2352x1568 · color fundus image: 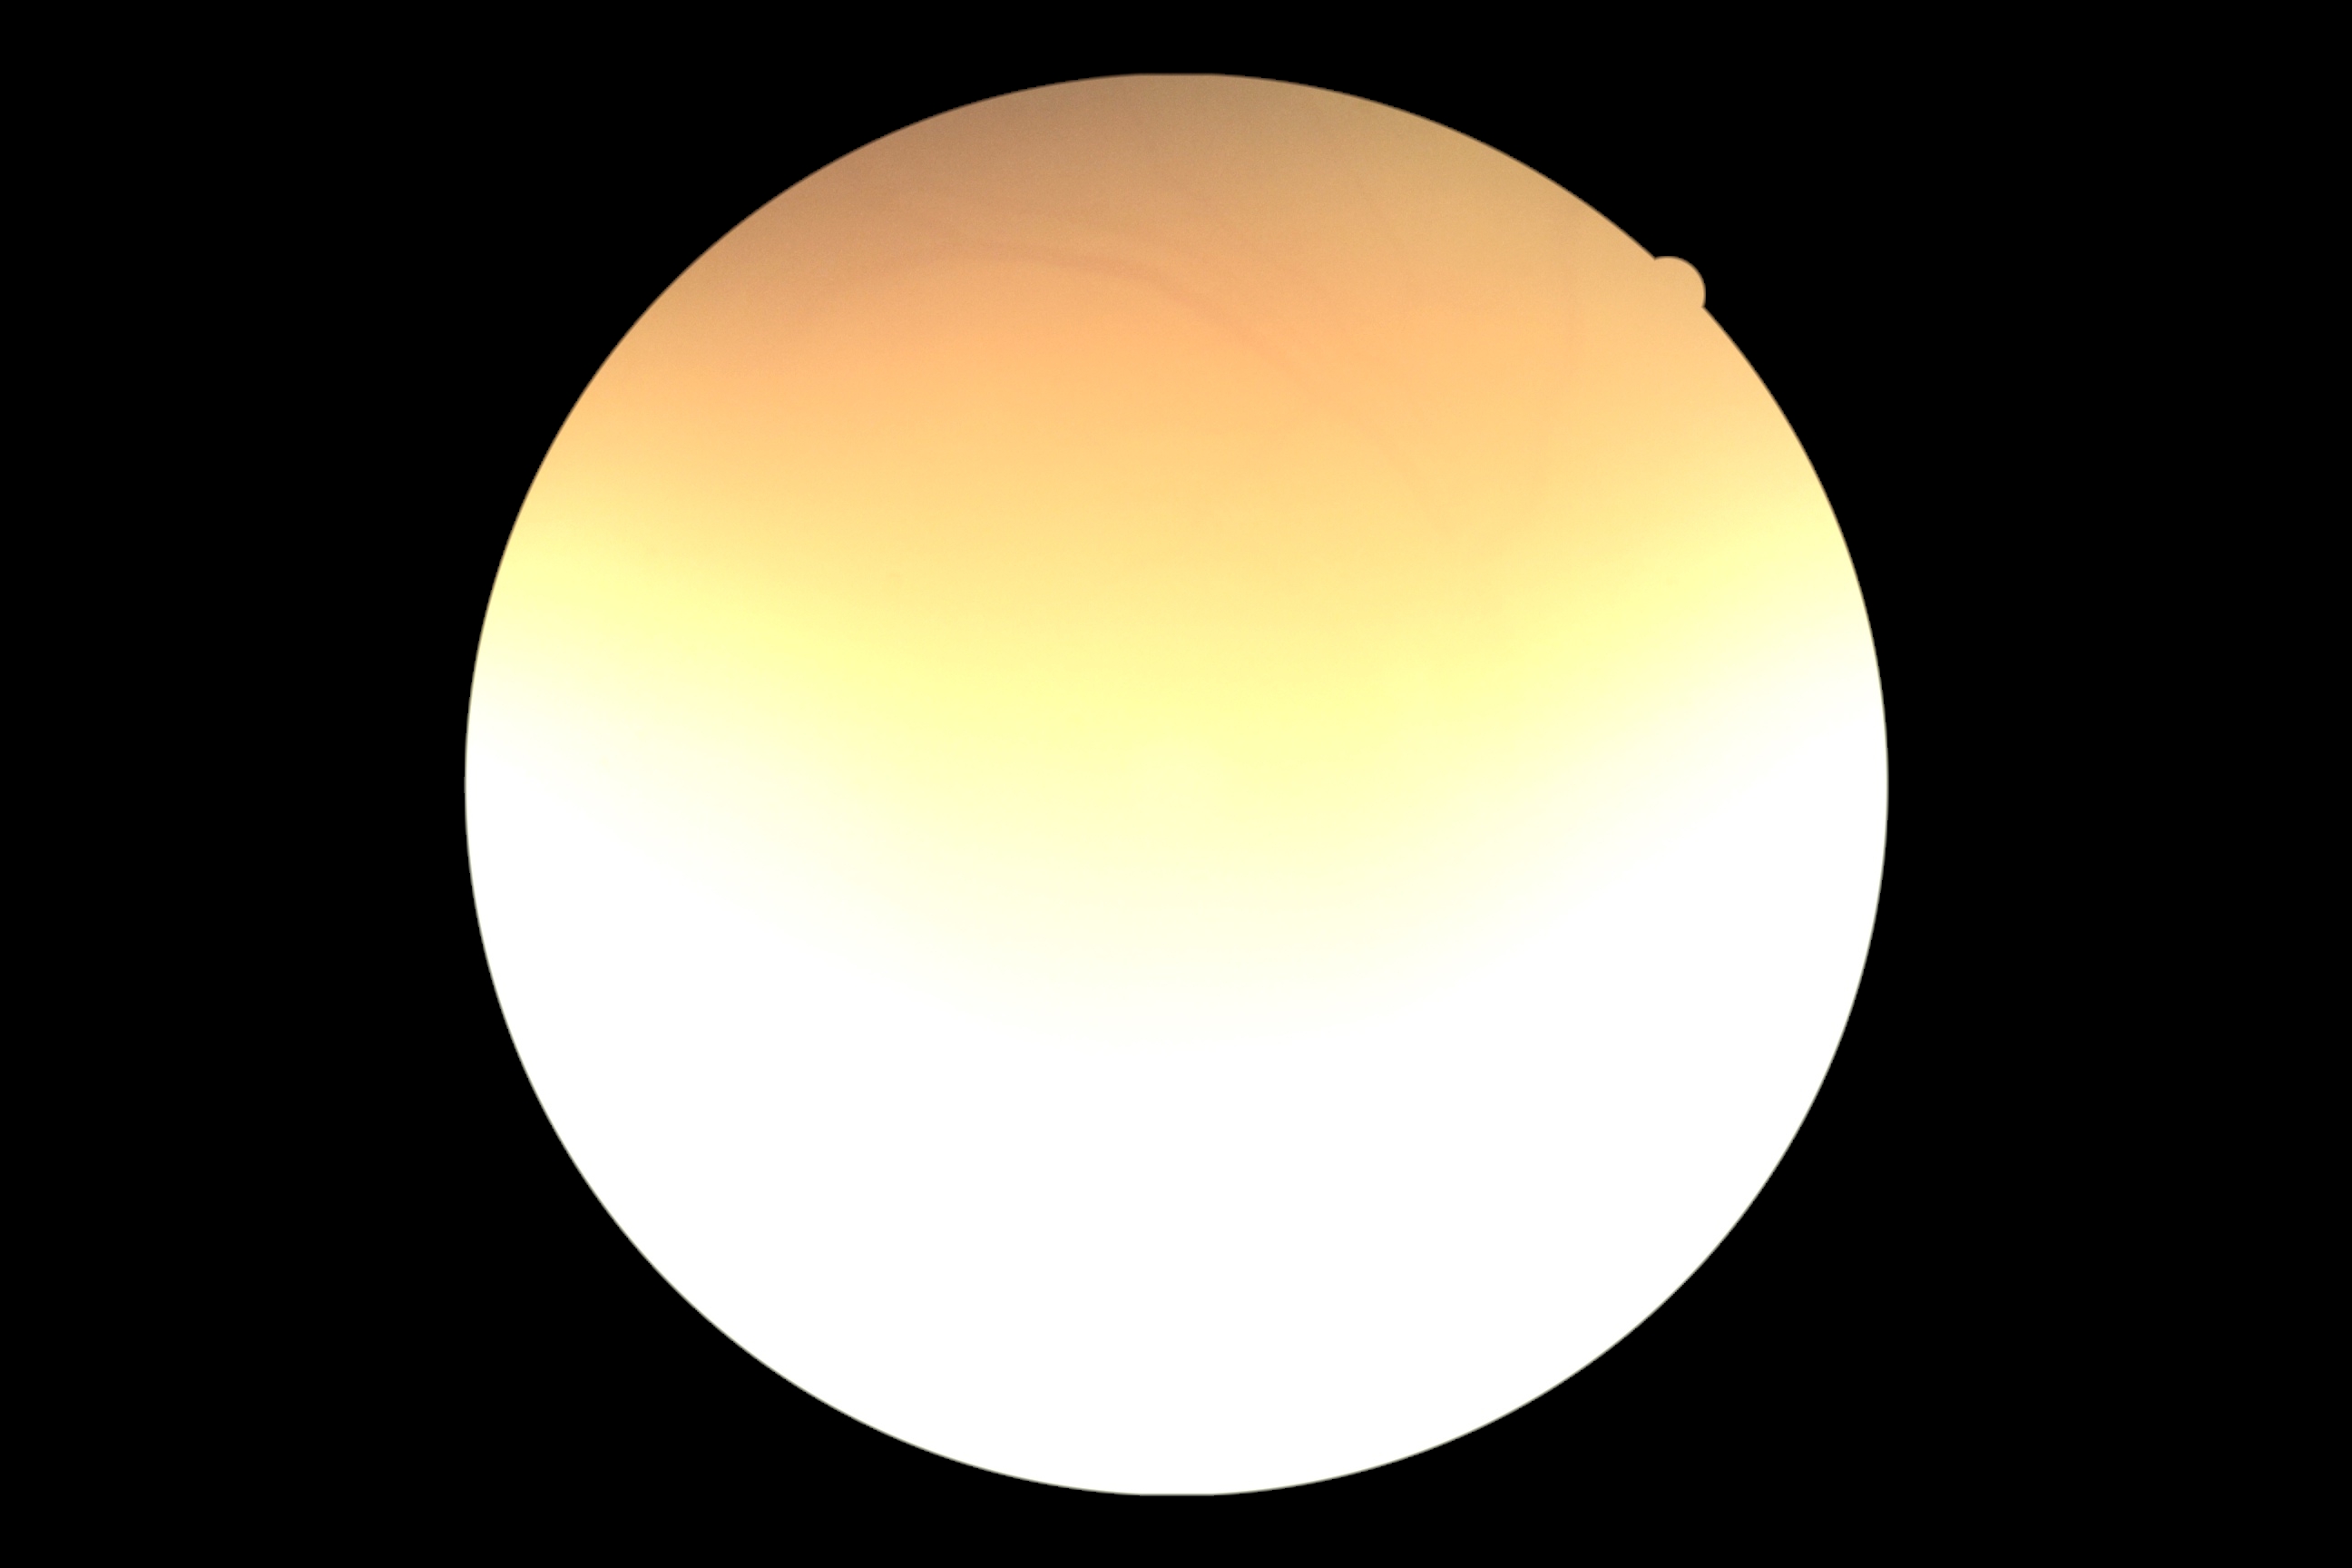

Image quality is insufficient for diabetic retinopathy assessment.
Diabetic retinopathy (DR): ungradable due to poor image quality.